Image size 640x480. Wide-field contact fundus photograph of an infant:
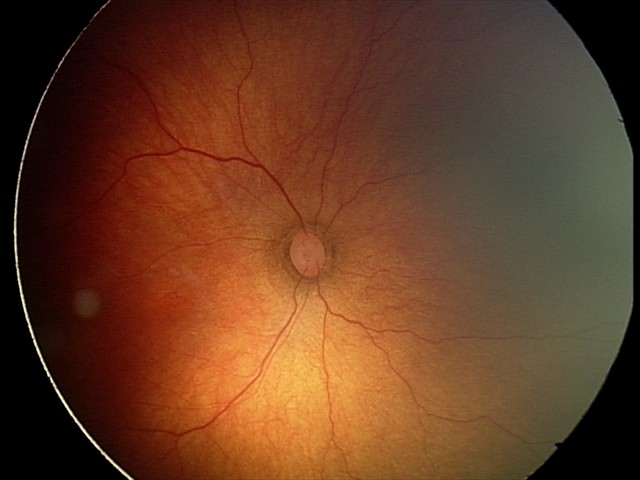
ROP diagnosis: stage 2.